848 by 848 pixels, no pharmacologic dilation — 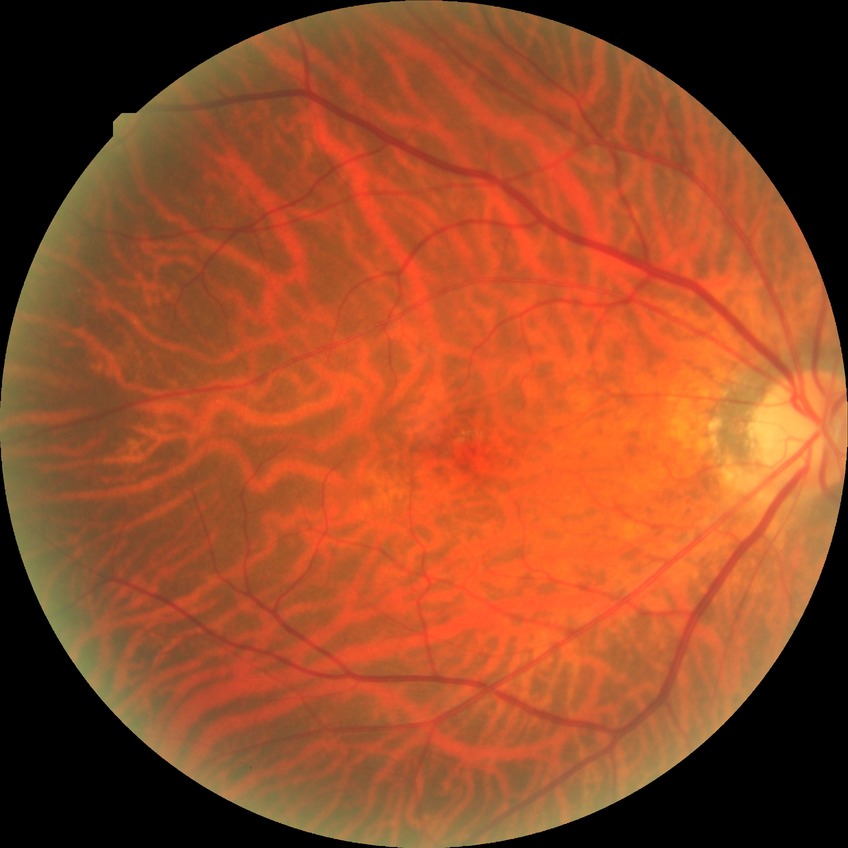 diabetic retinopathy (DR): NDR (no diabetic retinopathy)